45-degree field of view, retinal fundus photograph
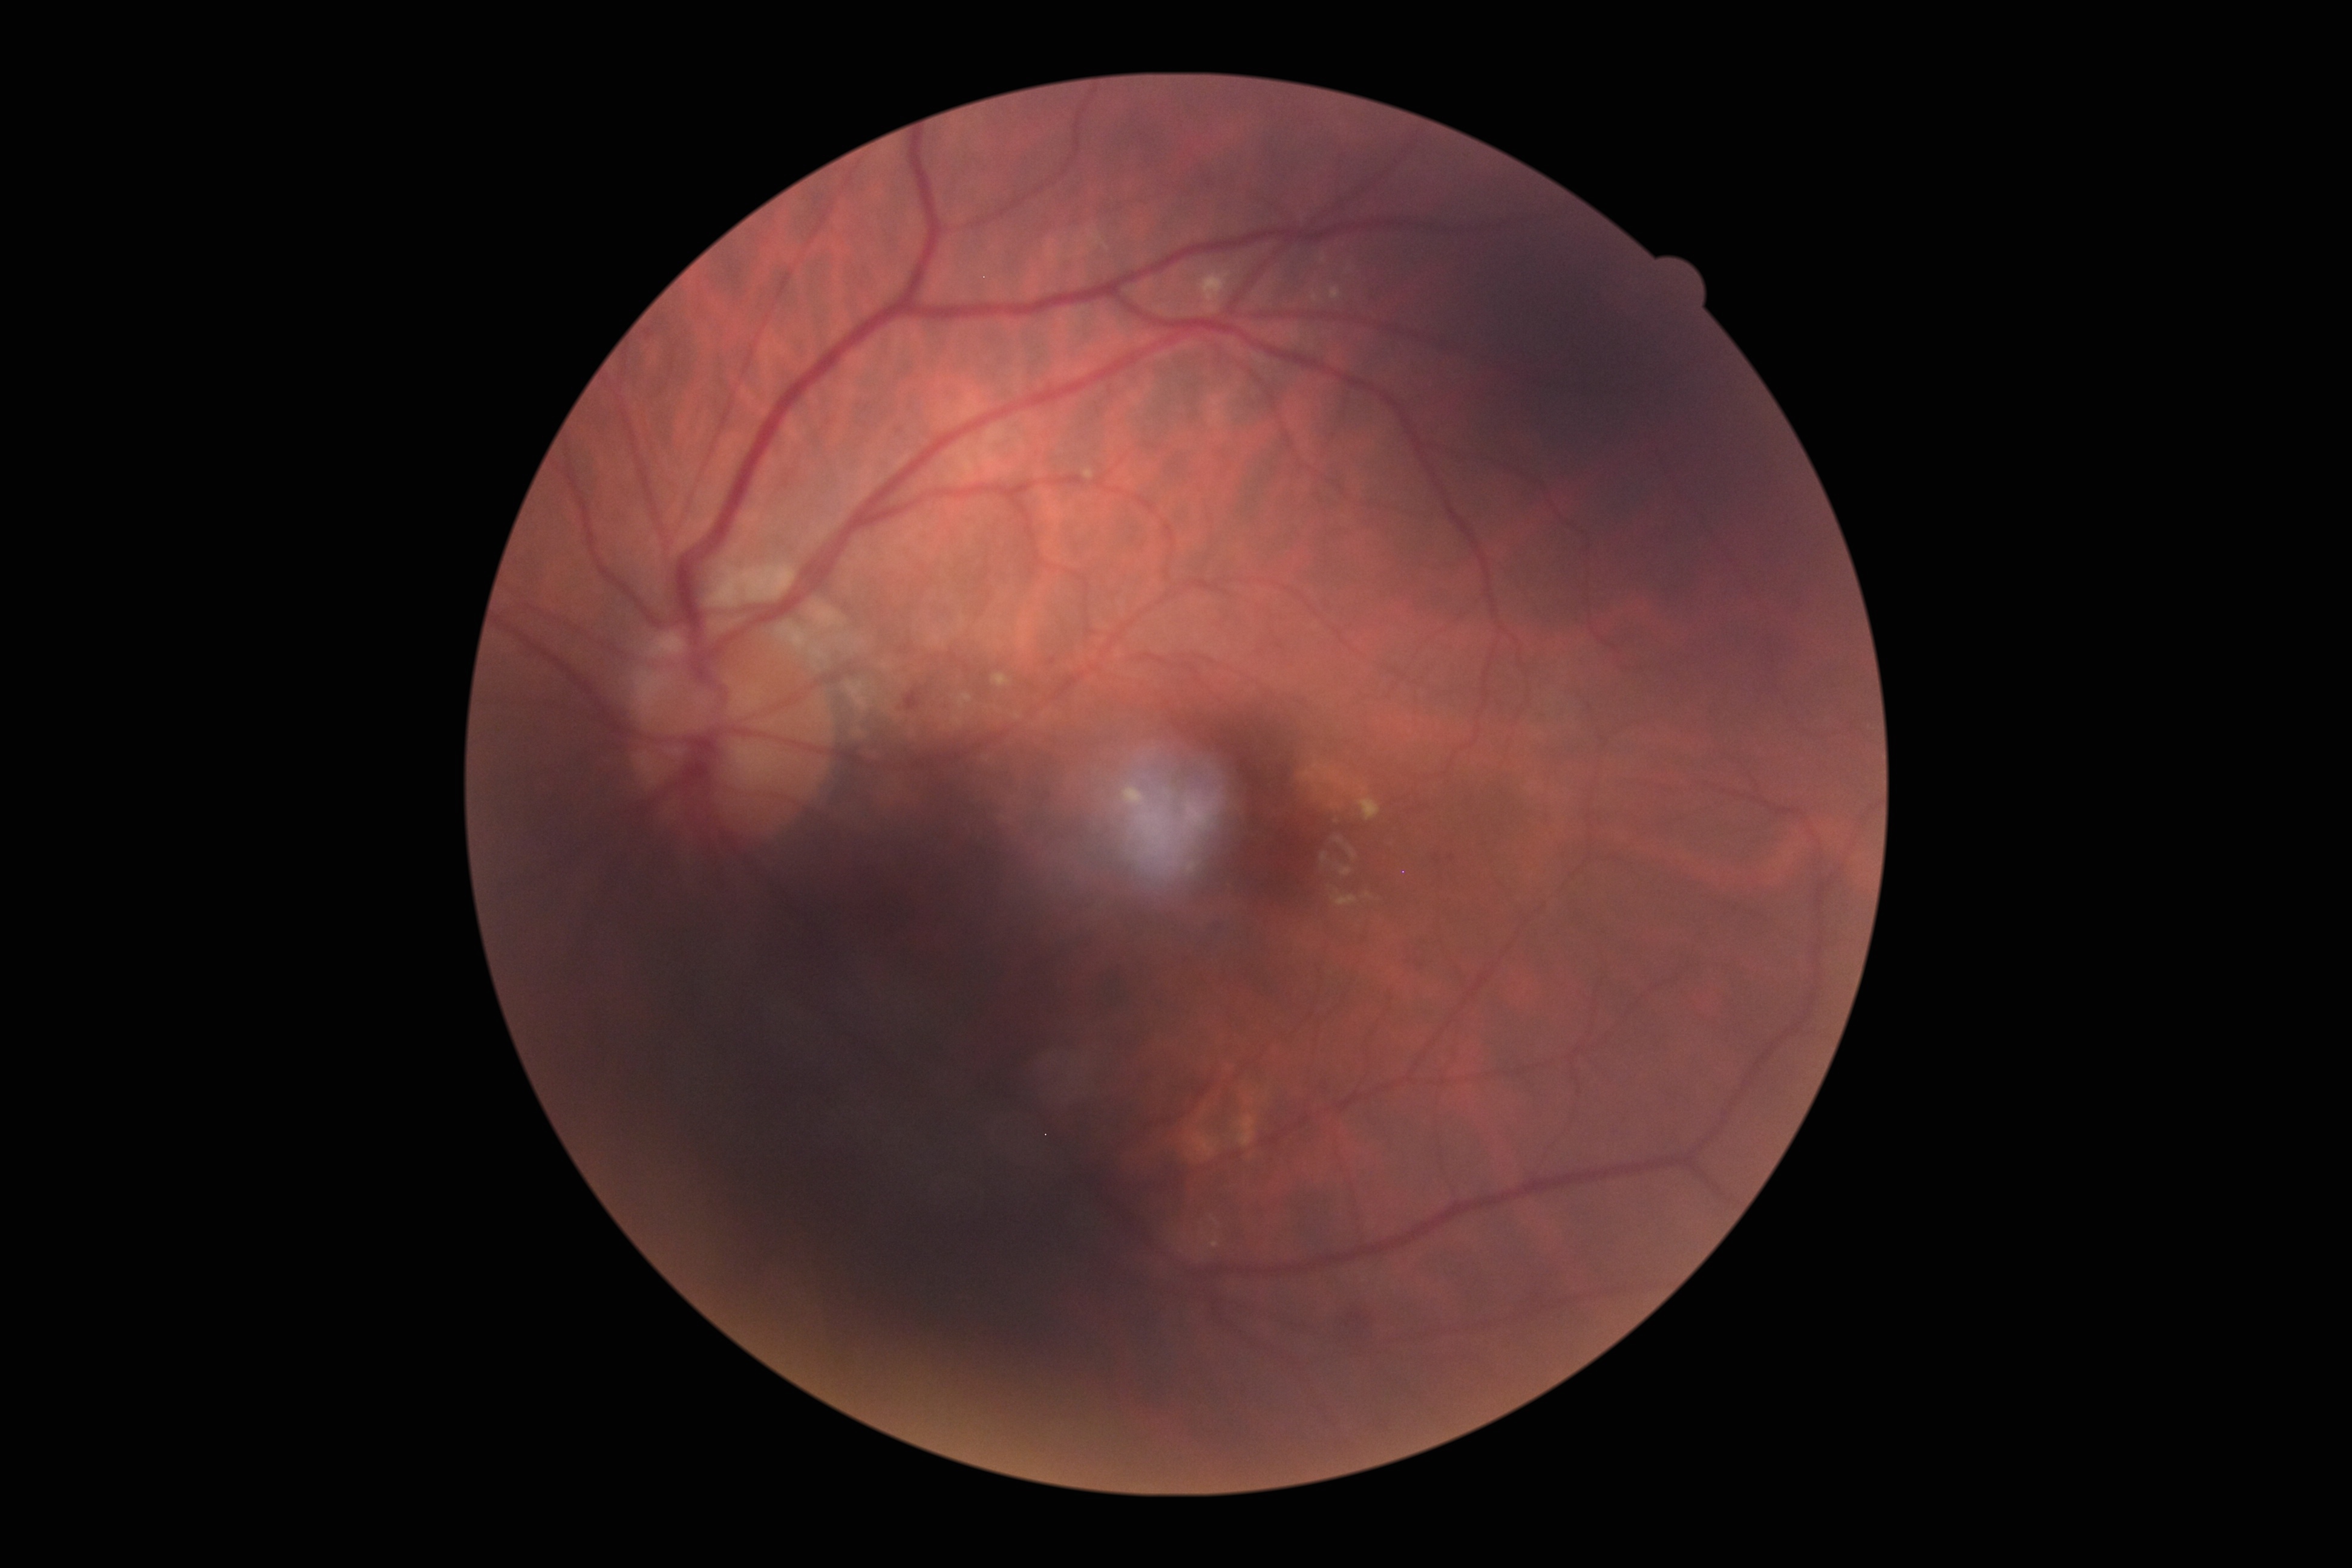

diabetic retinopathy (DR) = grade 2